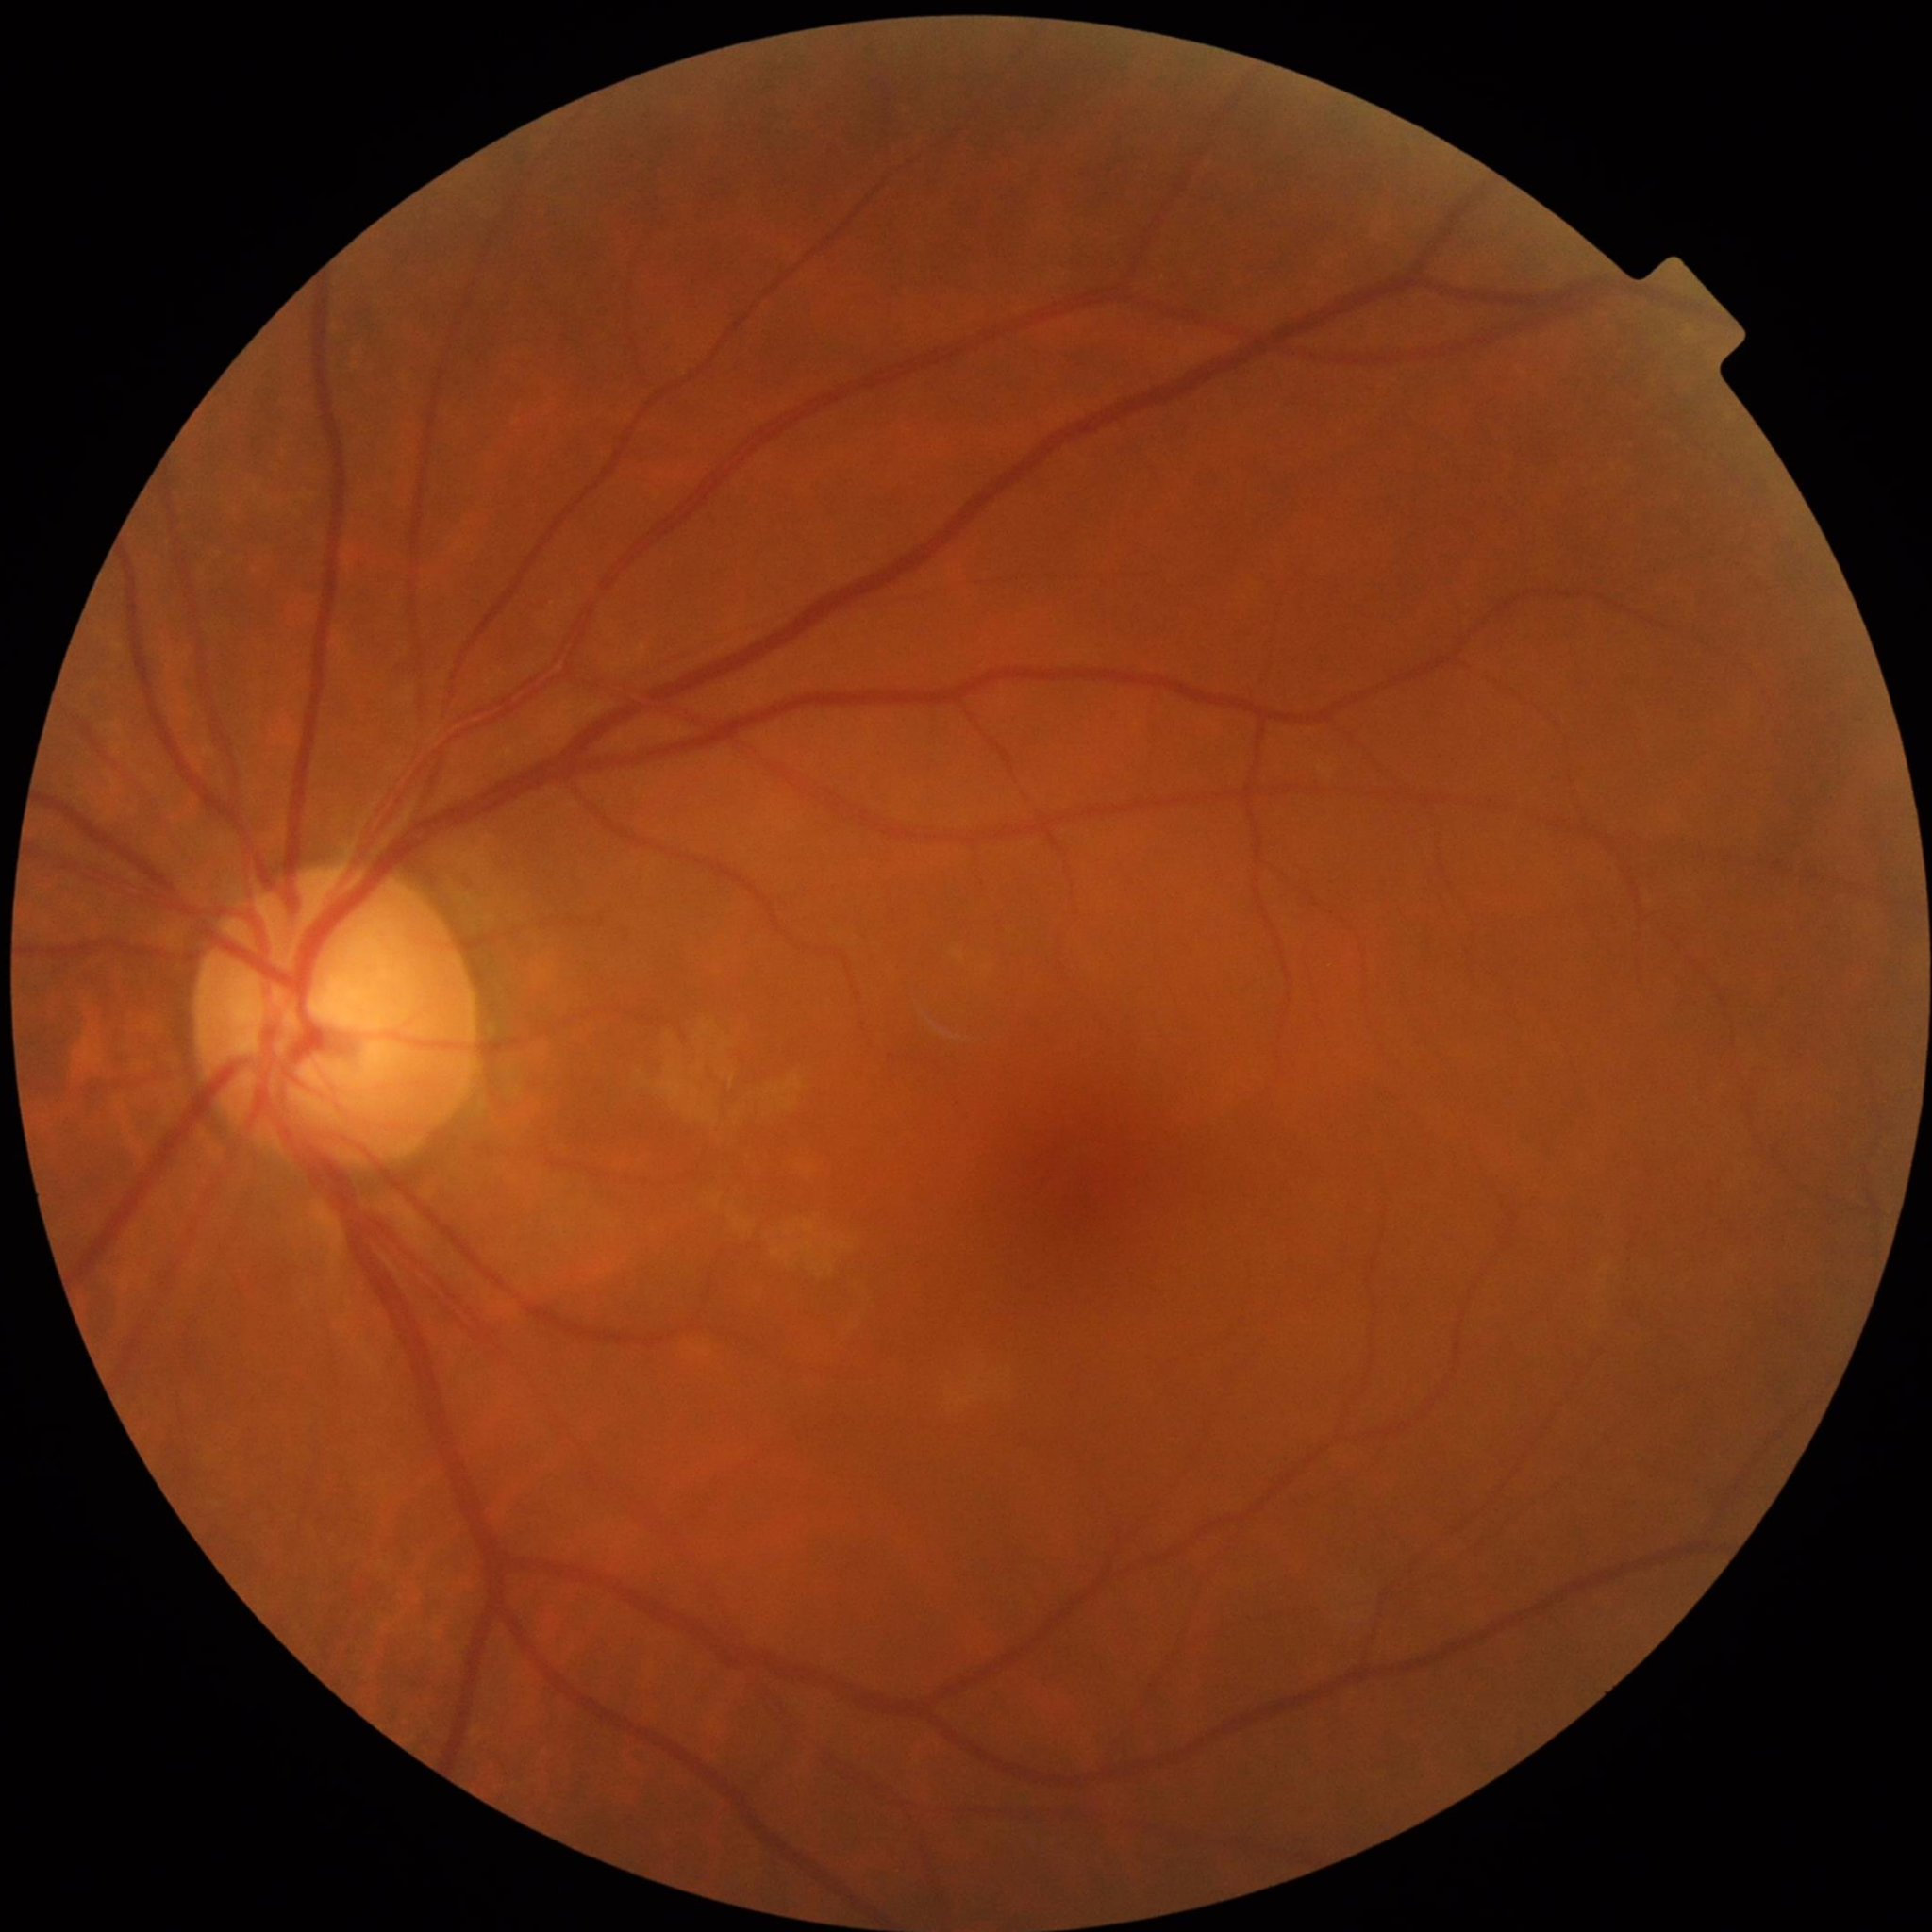
Control patient without diagnosed AMD, DR, or glaucoma. Image quality: no quality issues identified.